2352x1568: 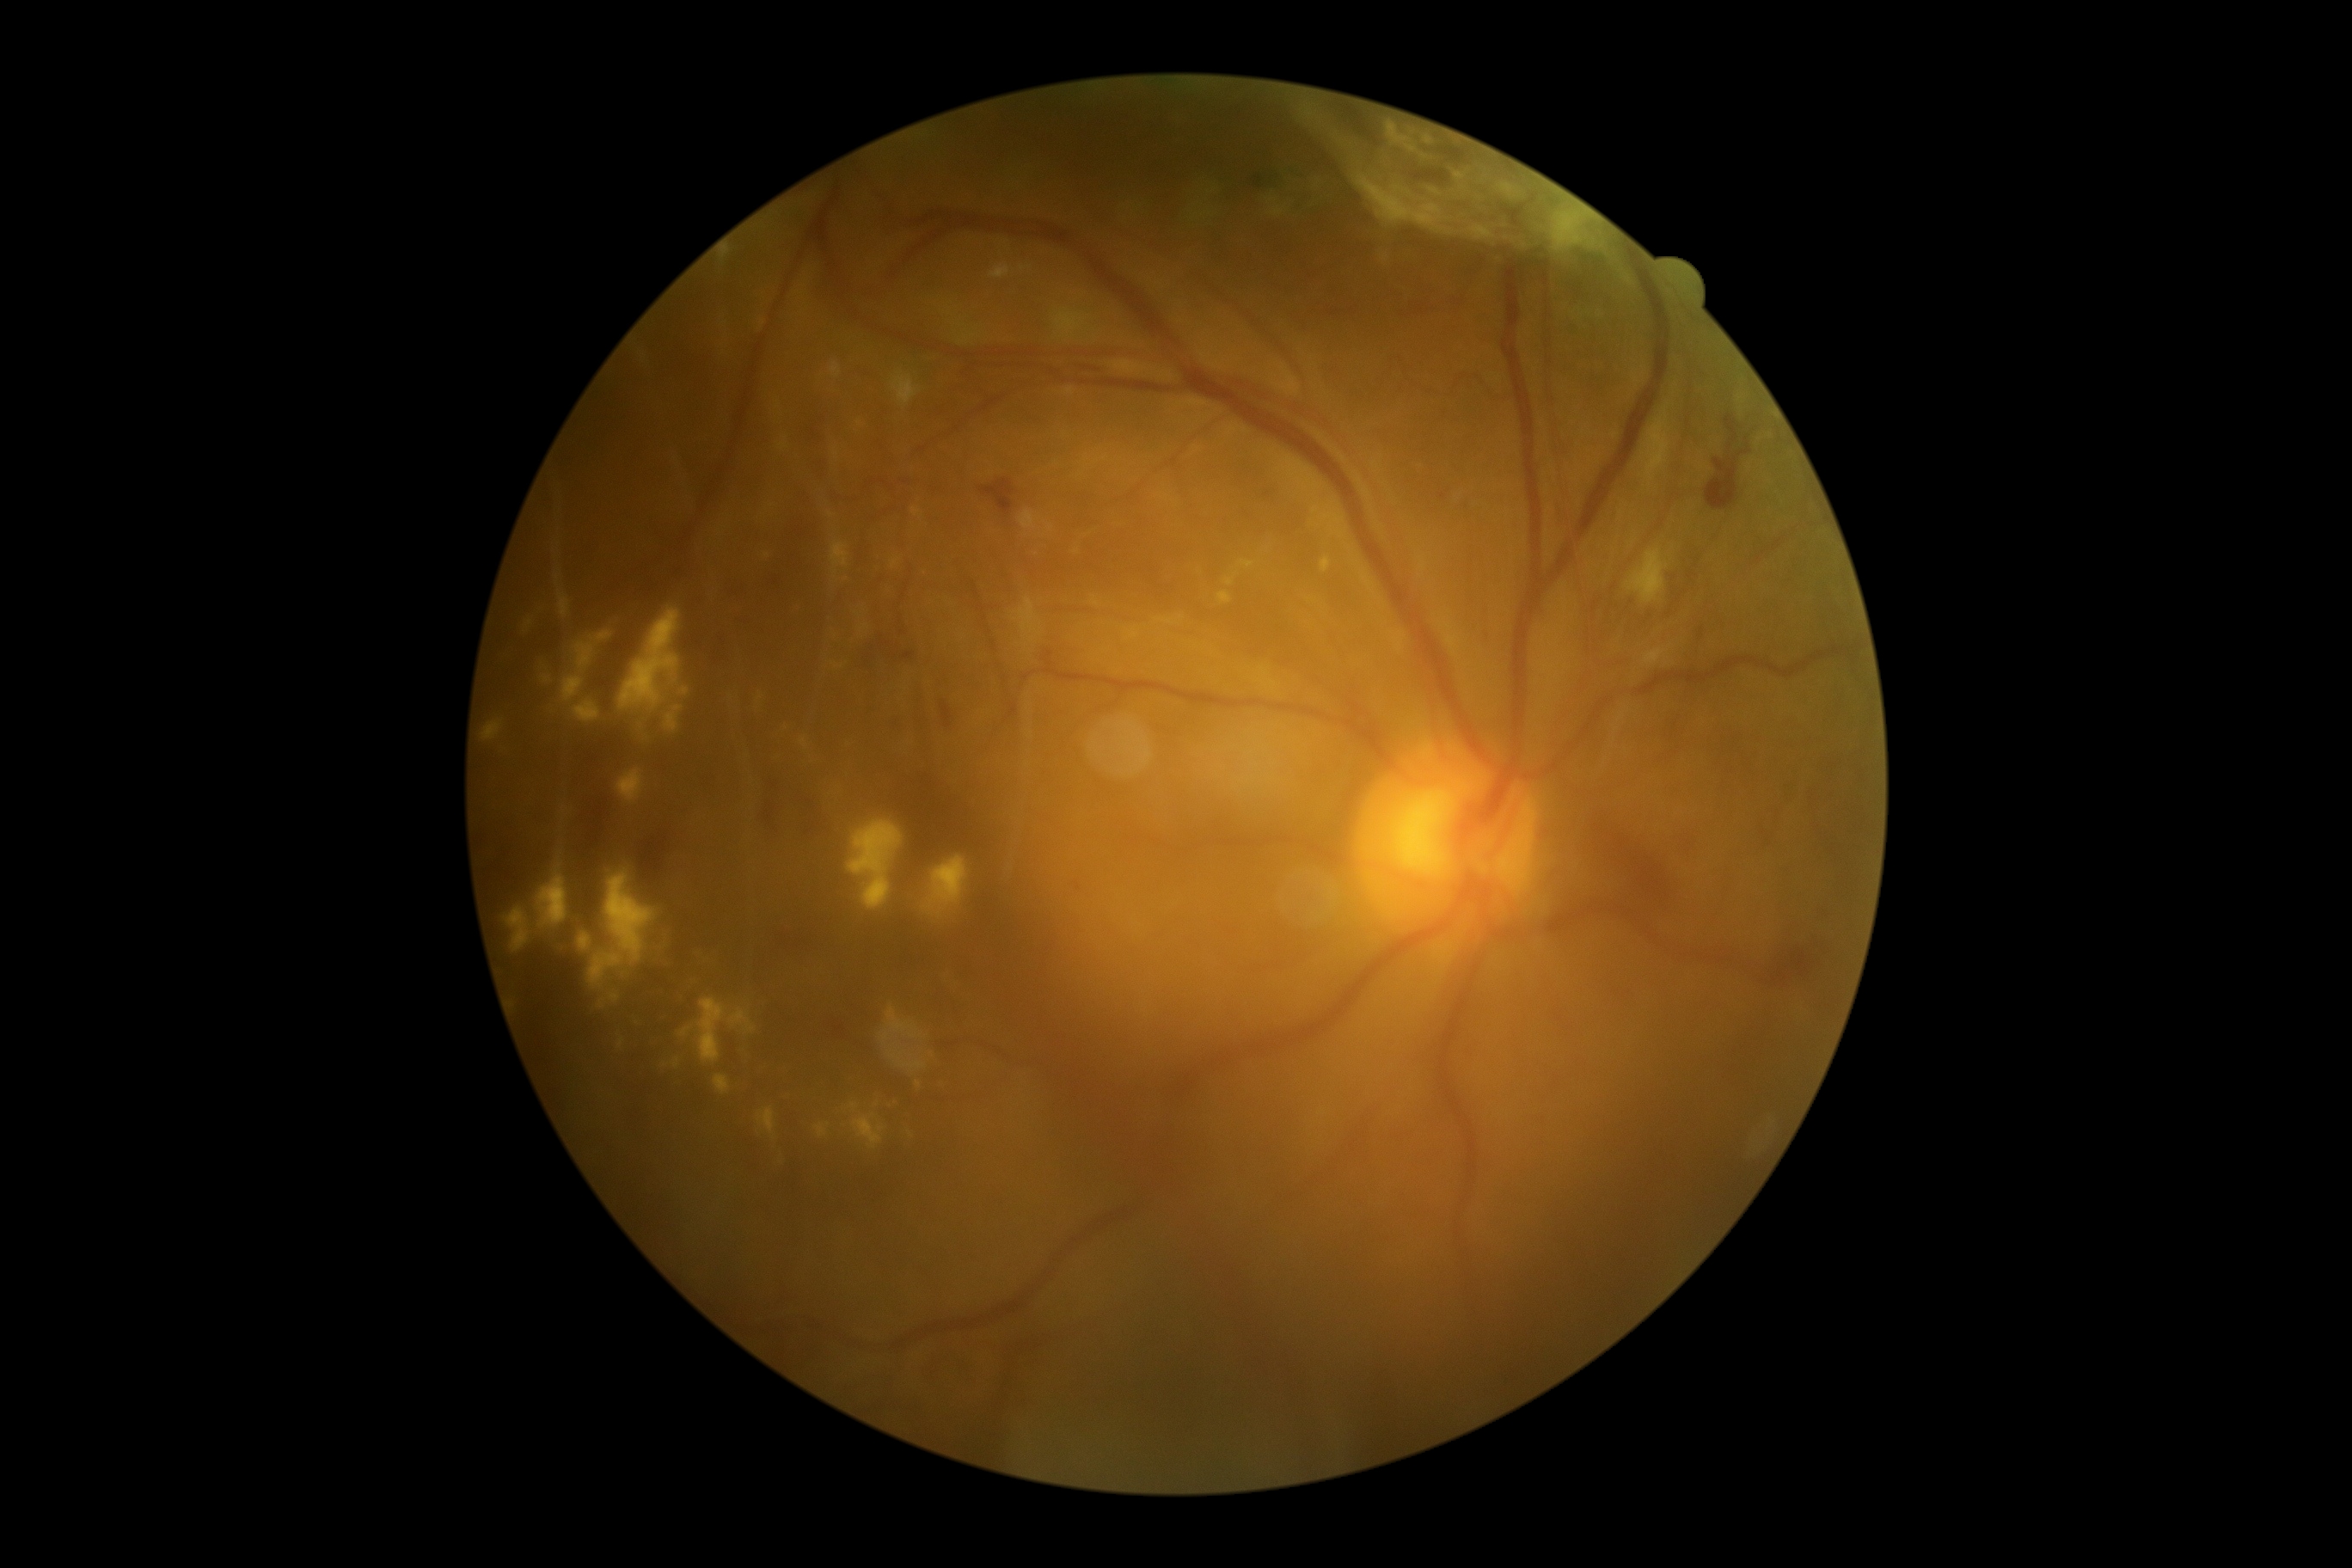
Diabetic retinopathy: PDR (grade 4)
Representative lesions:
hemorrhages (subset): box(1706, 444, 1751, 510), box(1259, 487, 1282, 508), box(983, 479, 1015, 515), box(508, 565, 680, 718), box(886, 718, 910, 738), box(1567, 807, 1675, 910), box(1402, 300, 1443, 319), box(1213, 921, 1244, 940), box(642, 831, 671, 895), box(1323, 307, 1356, 319), box(769, 1333, 836, 1381), box(573, 730, 642, 845), box(732, 582, 750, 601), box(855, 637, 922, 678), box(1663, 823, 1703, 861)
Additional small hemorrhages near point(1729, 447)
microaneurysms: absent
soft exudates: box(1626, 549, 1669, 604)
hard exudates (subset): box(780, 443, 788, 451), box(1156, 618, 1177, 625), box(912, 508, 922, 518), box(800, 738, 807, 749), box(830, 539, 850, 577), box(556, 575, 561, 585), box(1218, 592, 1232, 604), box(558, 589, 572, 620), box(886, 1043, 928, 1070), box(525, 618, 534, 632), box(879, 1005, 924, 1048), box(991, 267, 1010, 279), box(498, 871, 924, 1167), box(1093, 597, 1099, 606), box(848, 823, 902, 910)
Additional small hard exudates near point(837, 455), point(1051, 527), point(860, 424), point(919, 1085)